Color fundus image: 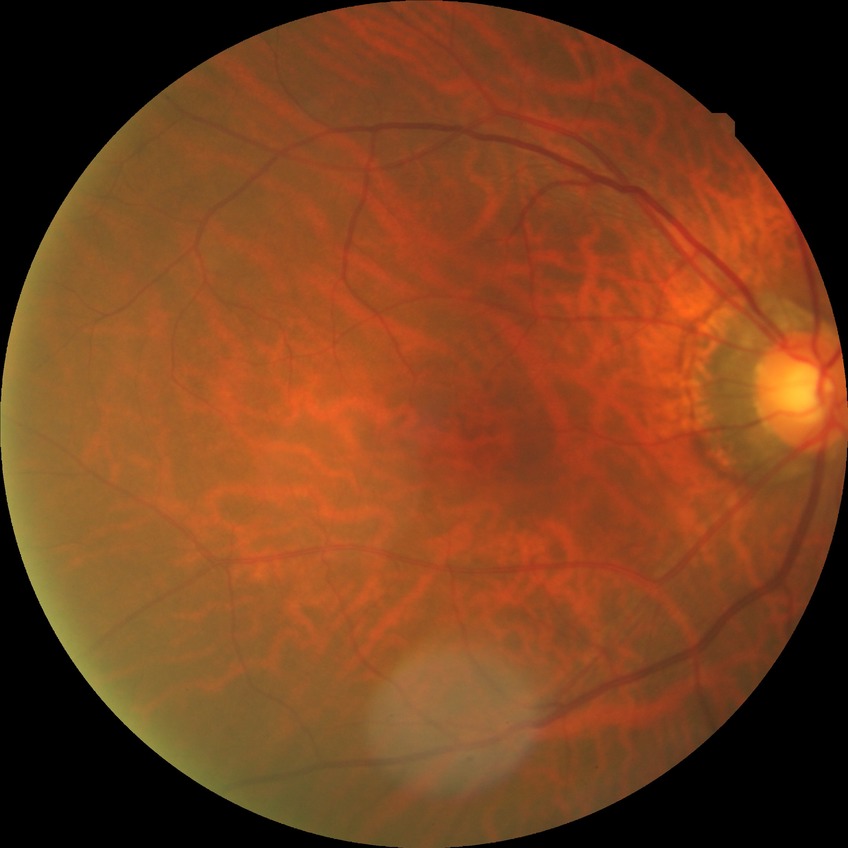

{
  "davis_grade": "NDR"
}